Pediatric wide-field fundus photograph.
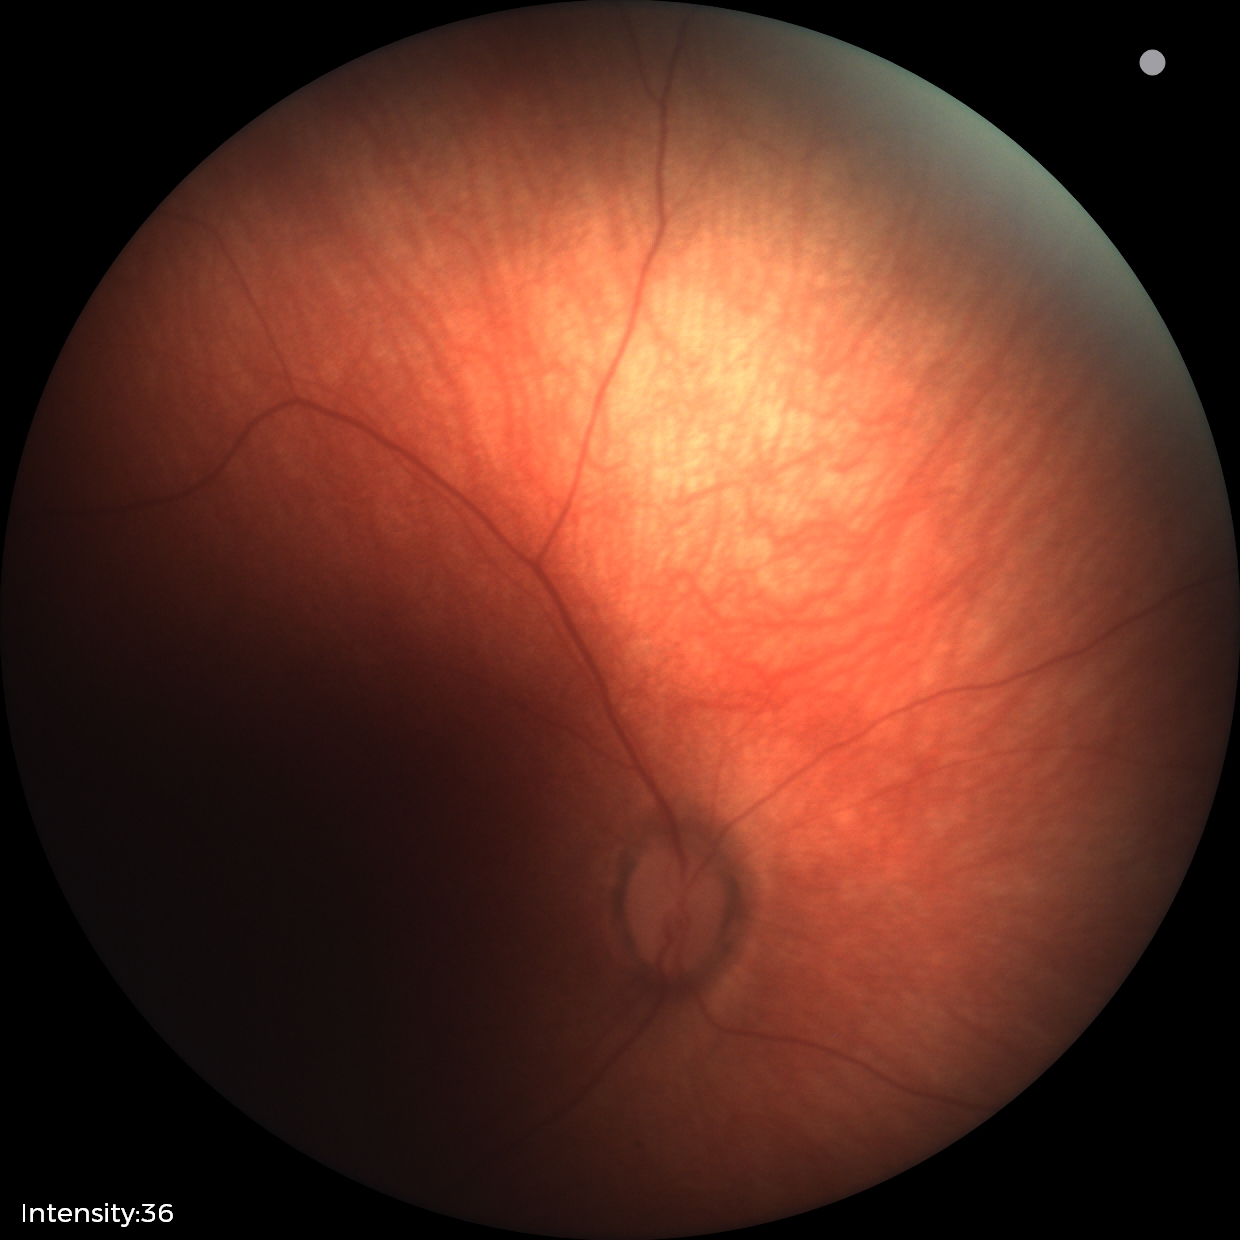 Physiological retinal appearance for postconceptual age.